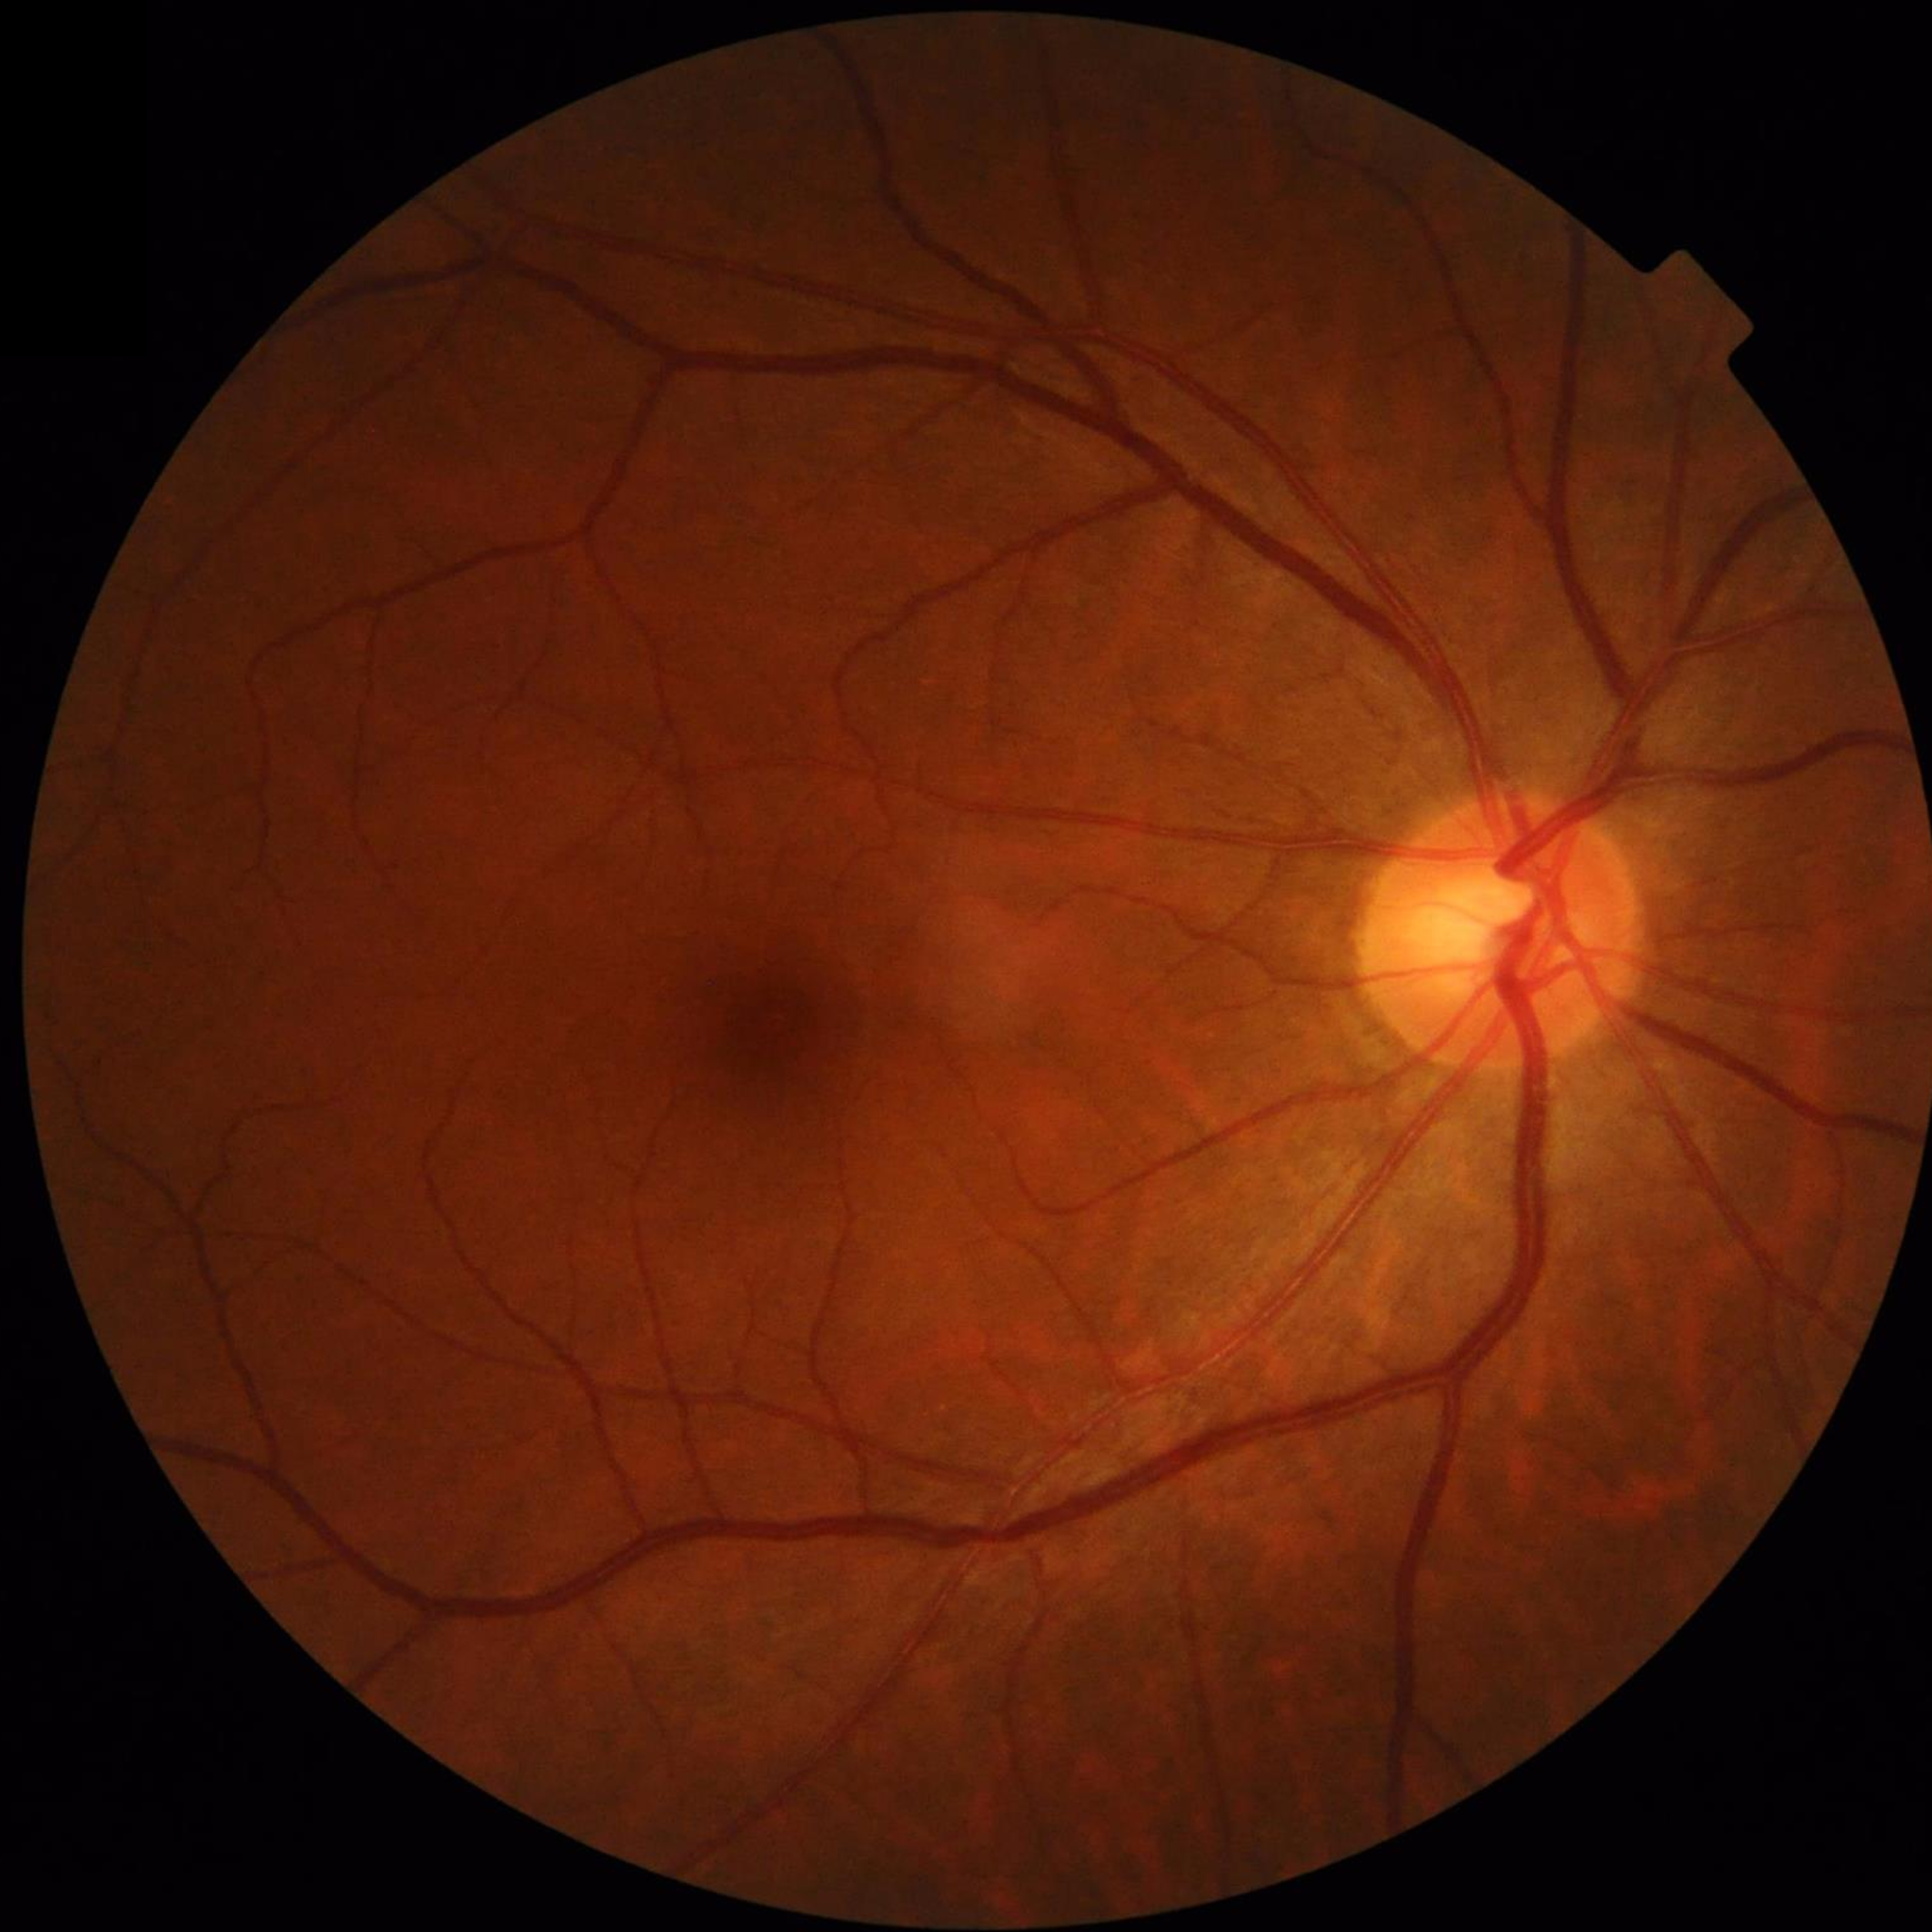
Quality: contrast adequate, no blur, illumination and color satisfactory.
Color fundus photograph with no signs of AMD, diabetic retinopathy, or glaucoma.